848x848px — 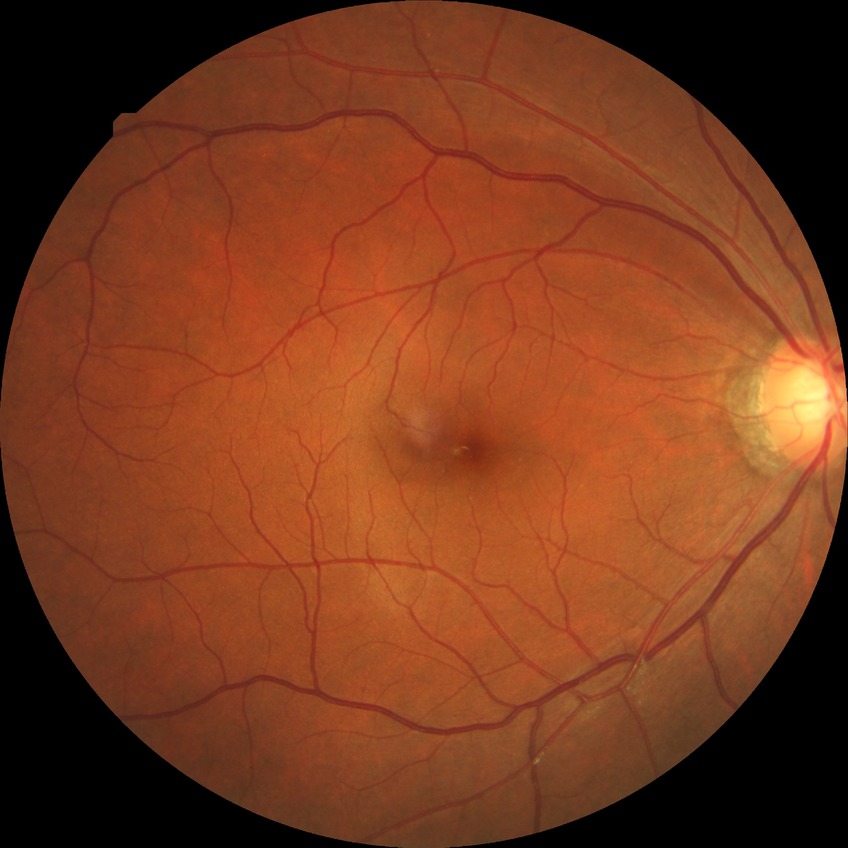 DR stage: NDR; DR impression: no apparent DR.